45 degree fundus photograph · no pharmacologic dilation
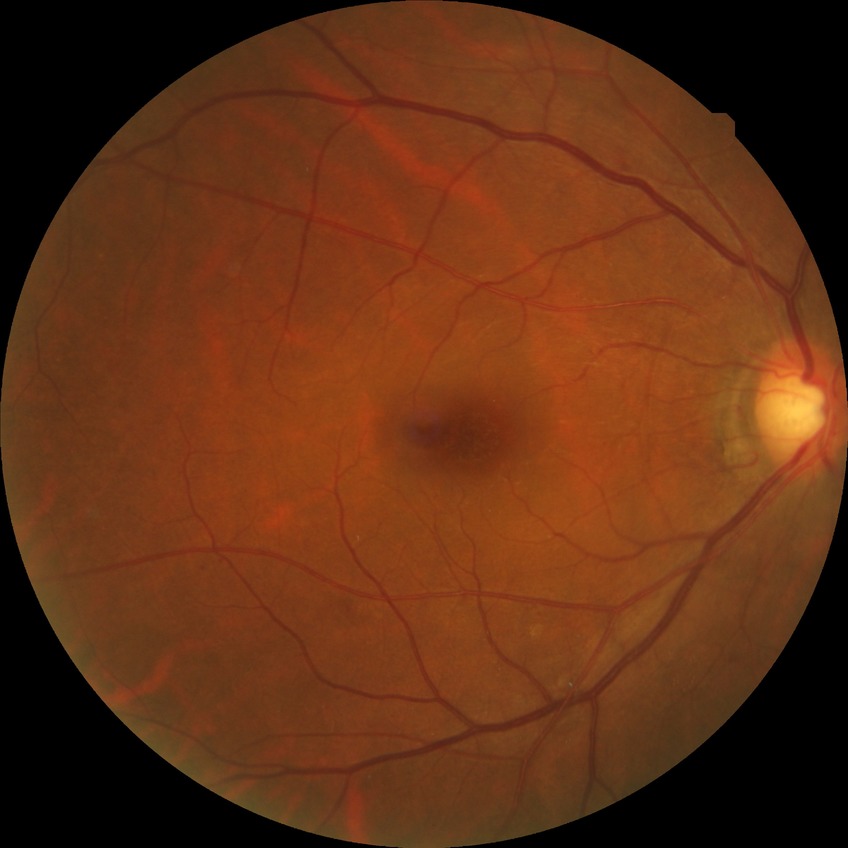 {
  "davis_grade": "simple diabetic retinopathy"
}